Non-mydriatic fundus camera · color fundus image: 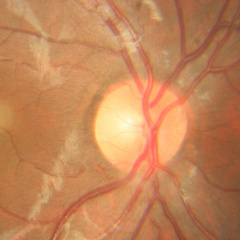
The image shows no signs of glaucoma.